45-degree field of view — 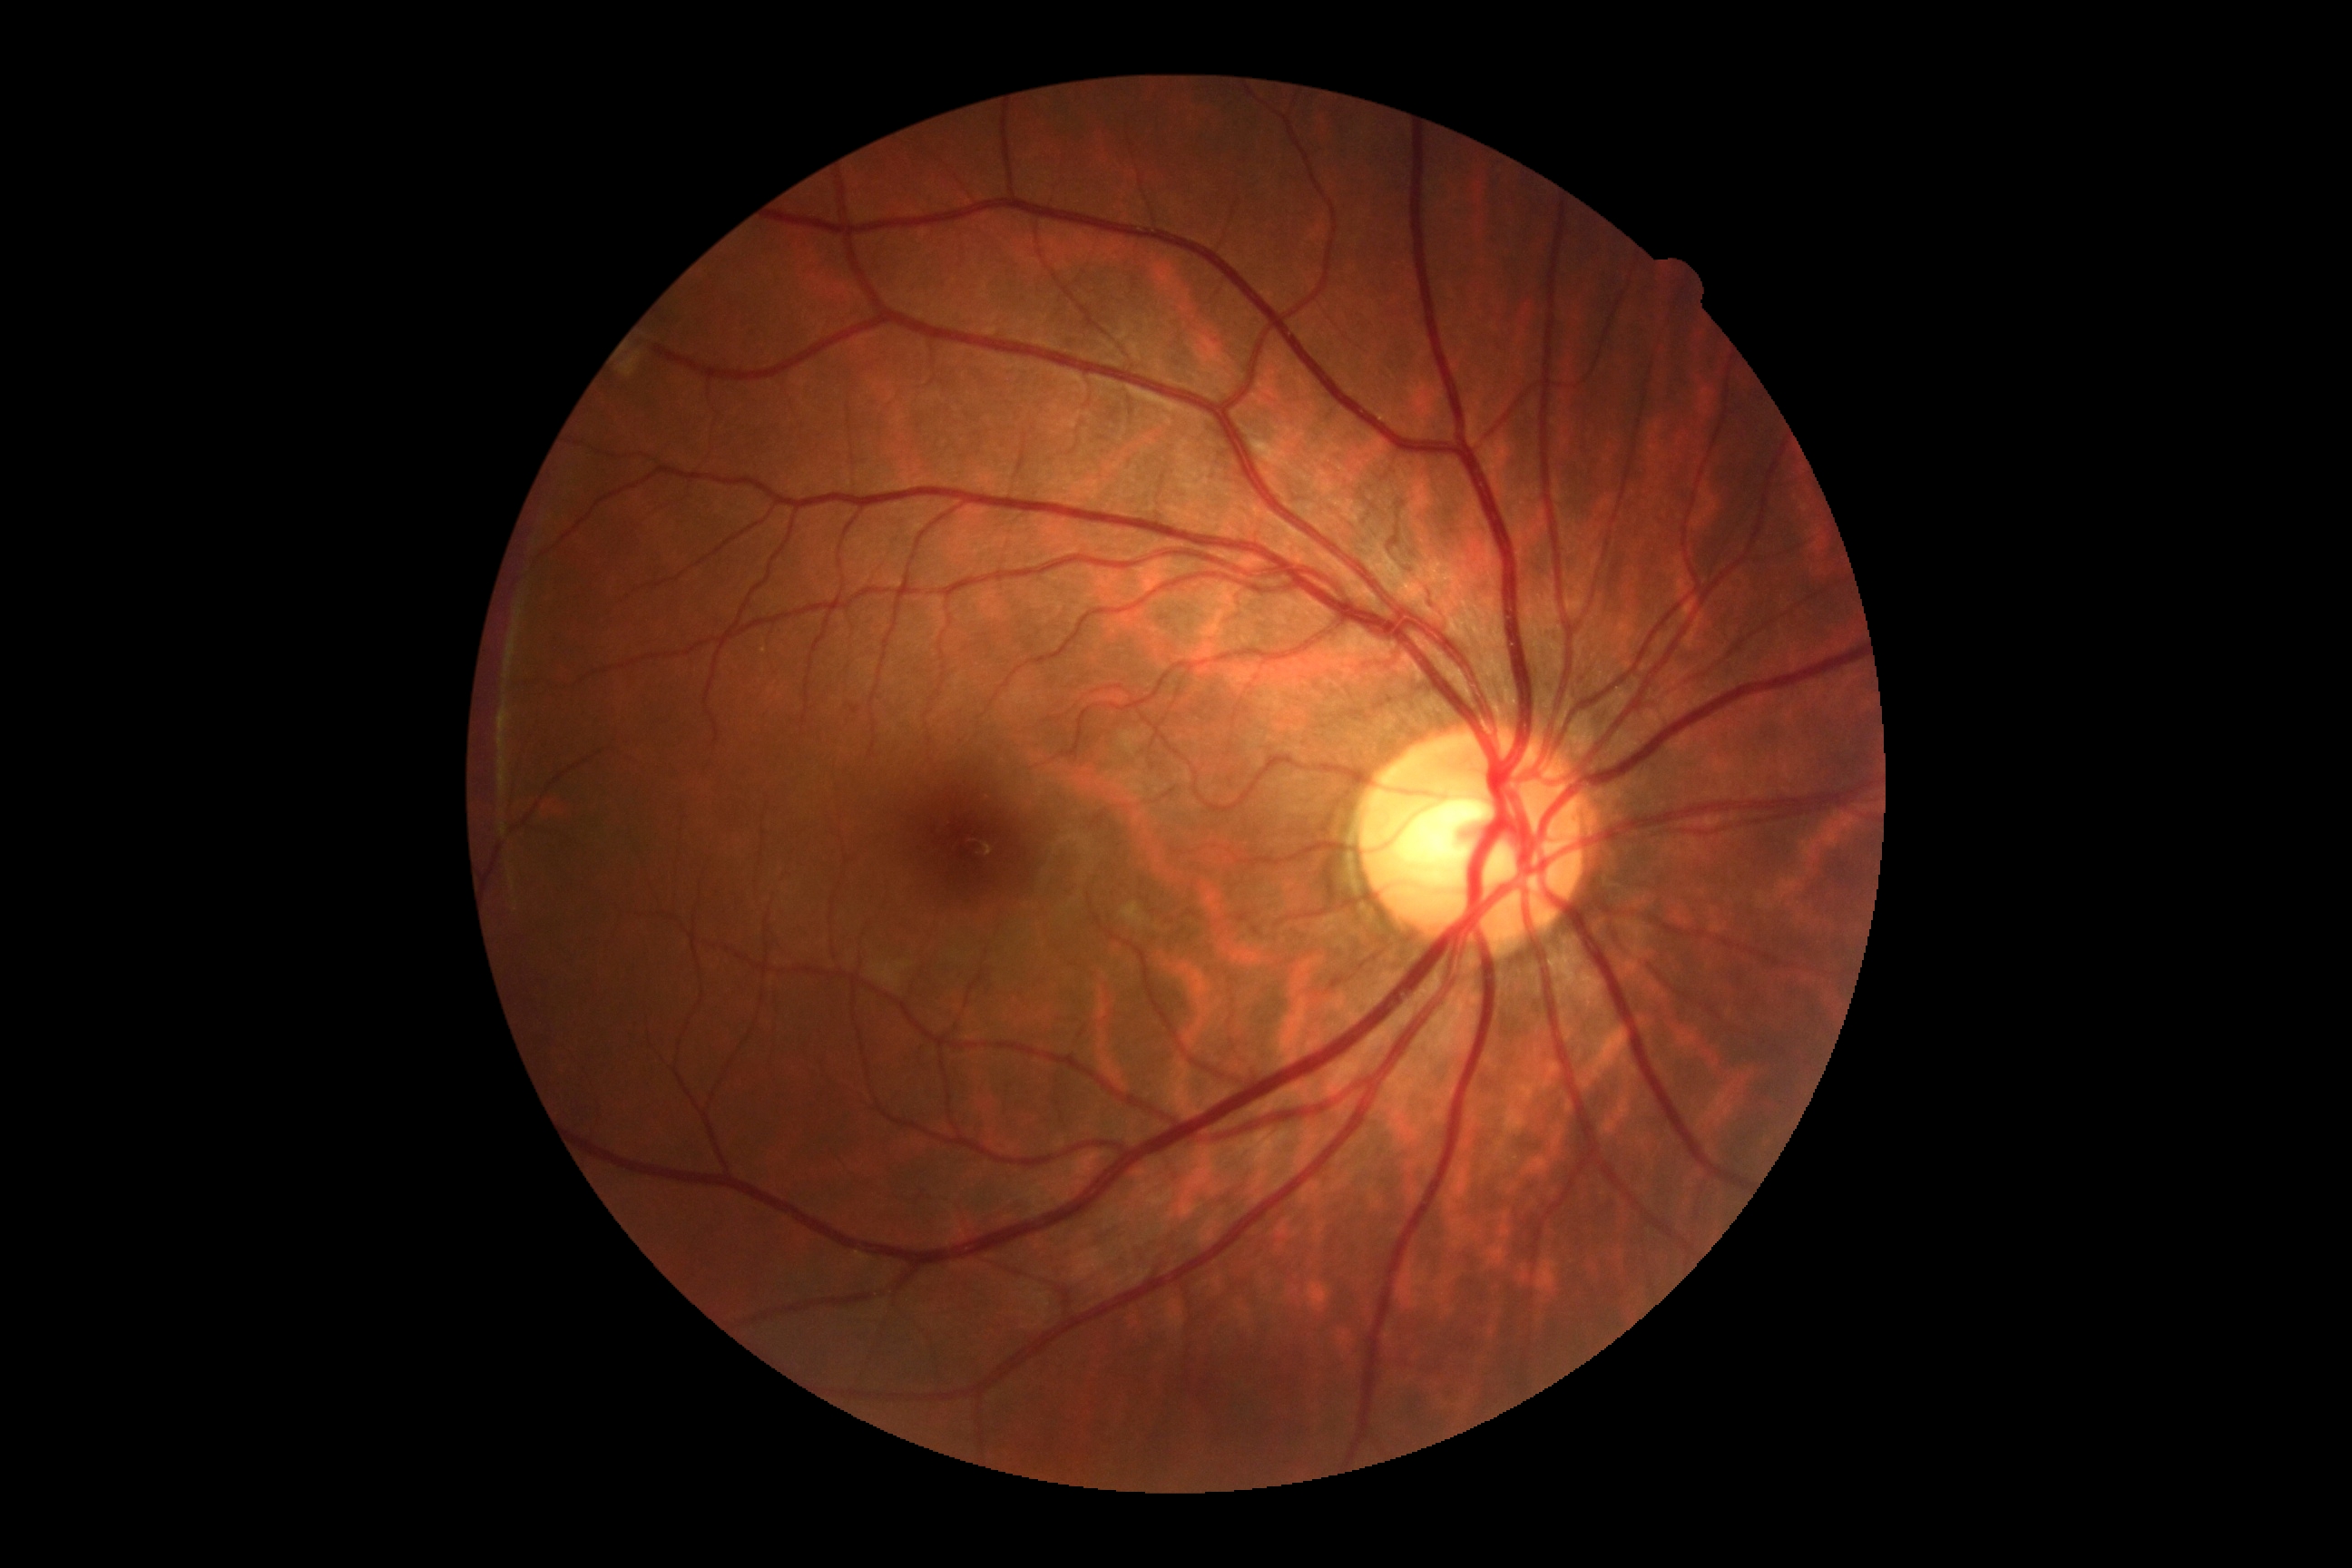
diabetic retinopathy (DR) = 0; DR impression = no signs of DR.